848x848 · DR severity per modified Davis staging.
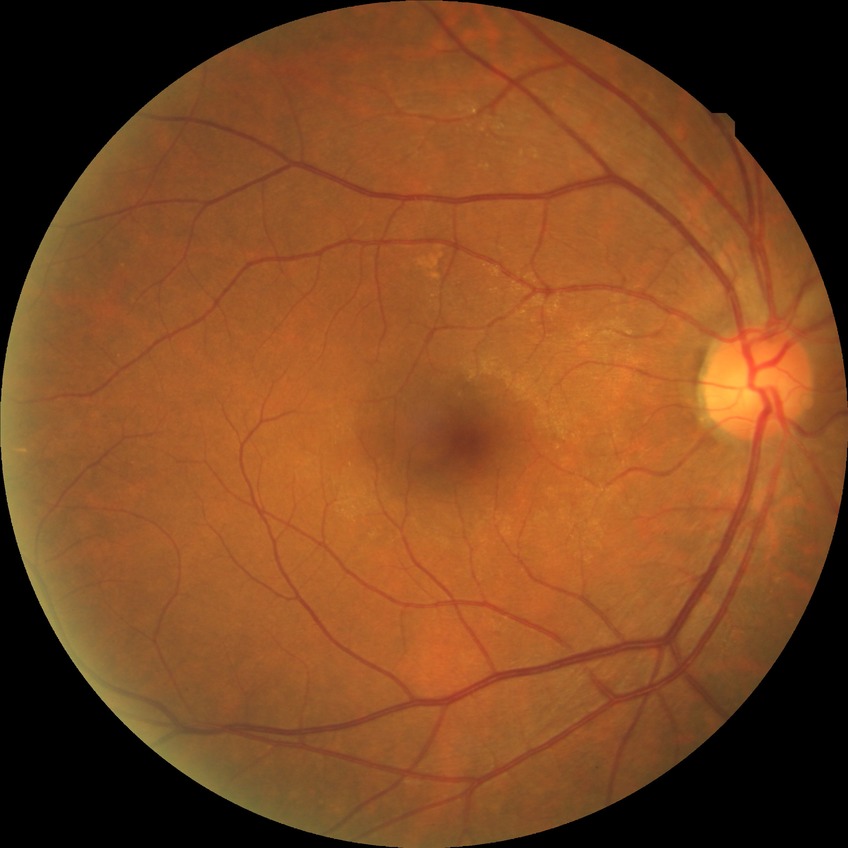 DR impression@no signs of DR; Davis stage@NDR.